2048 x 1536 pixels · CFP — 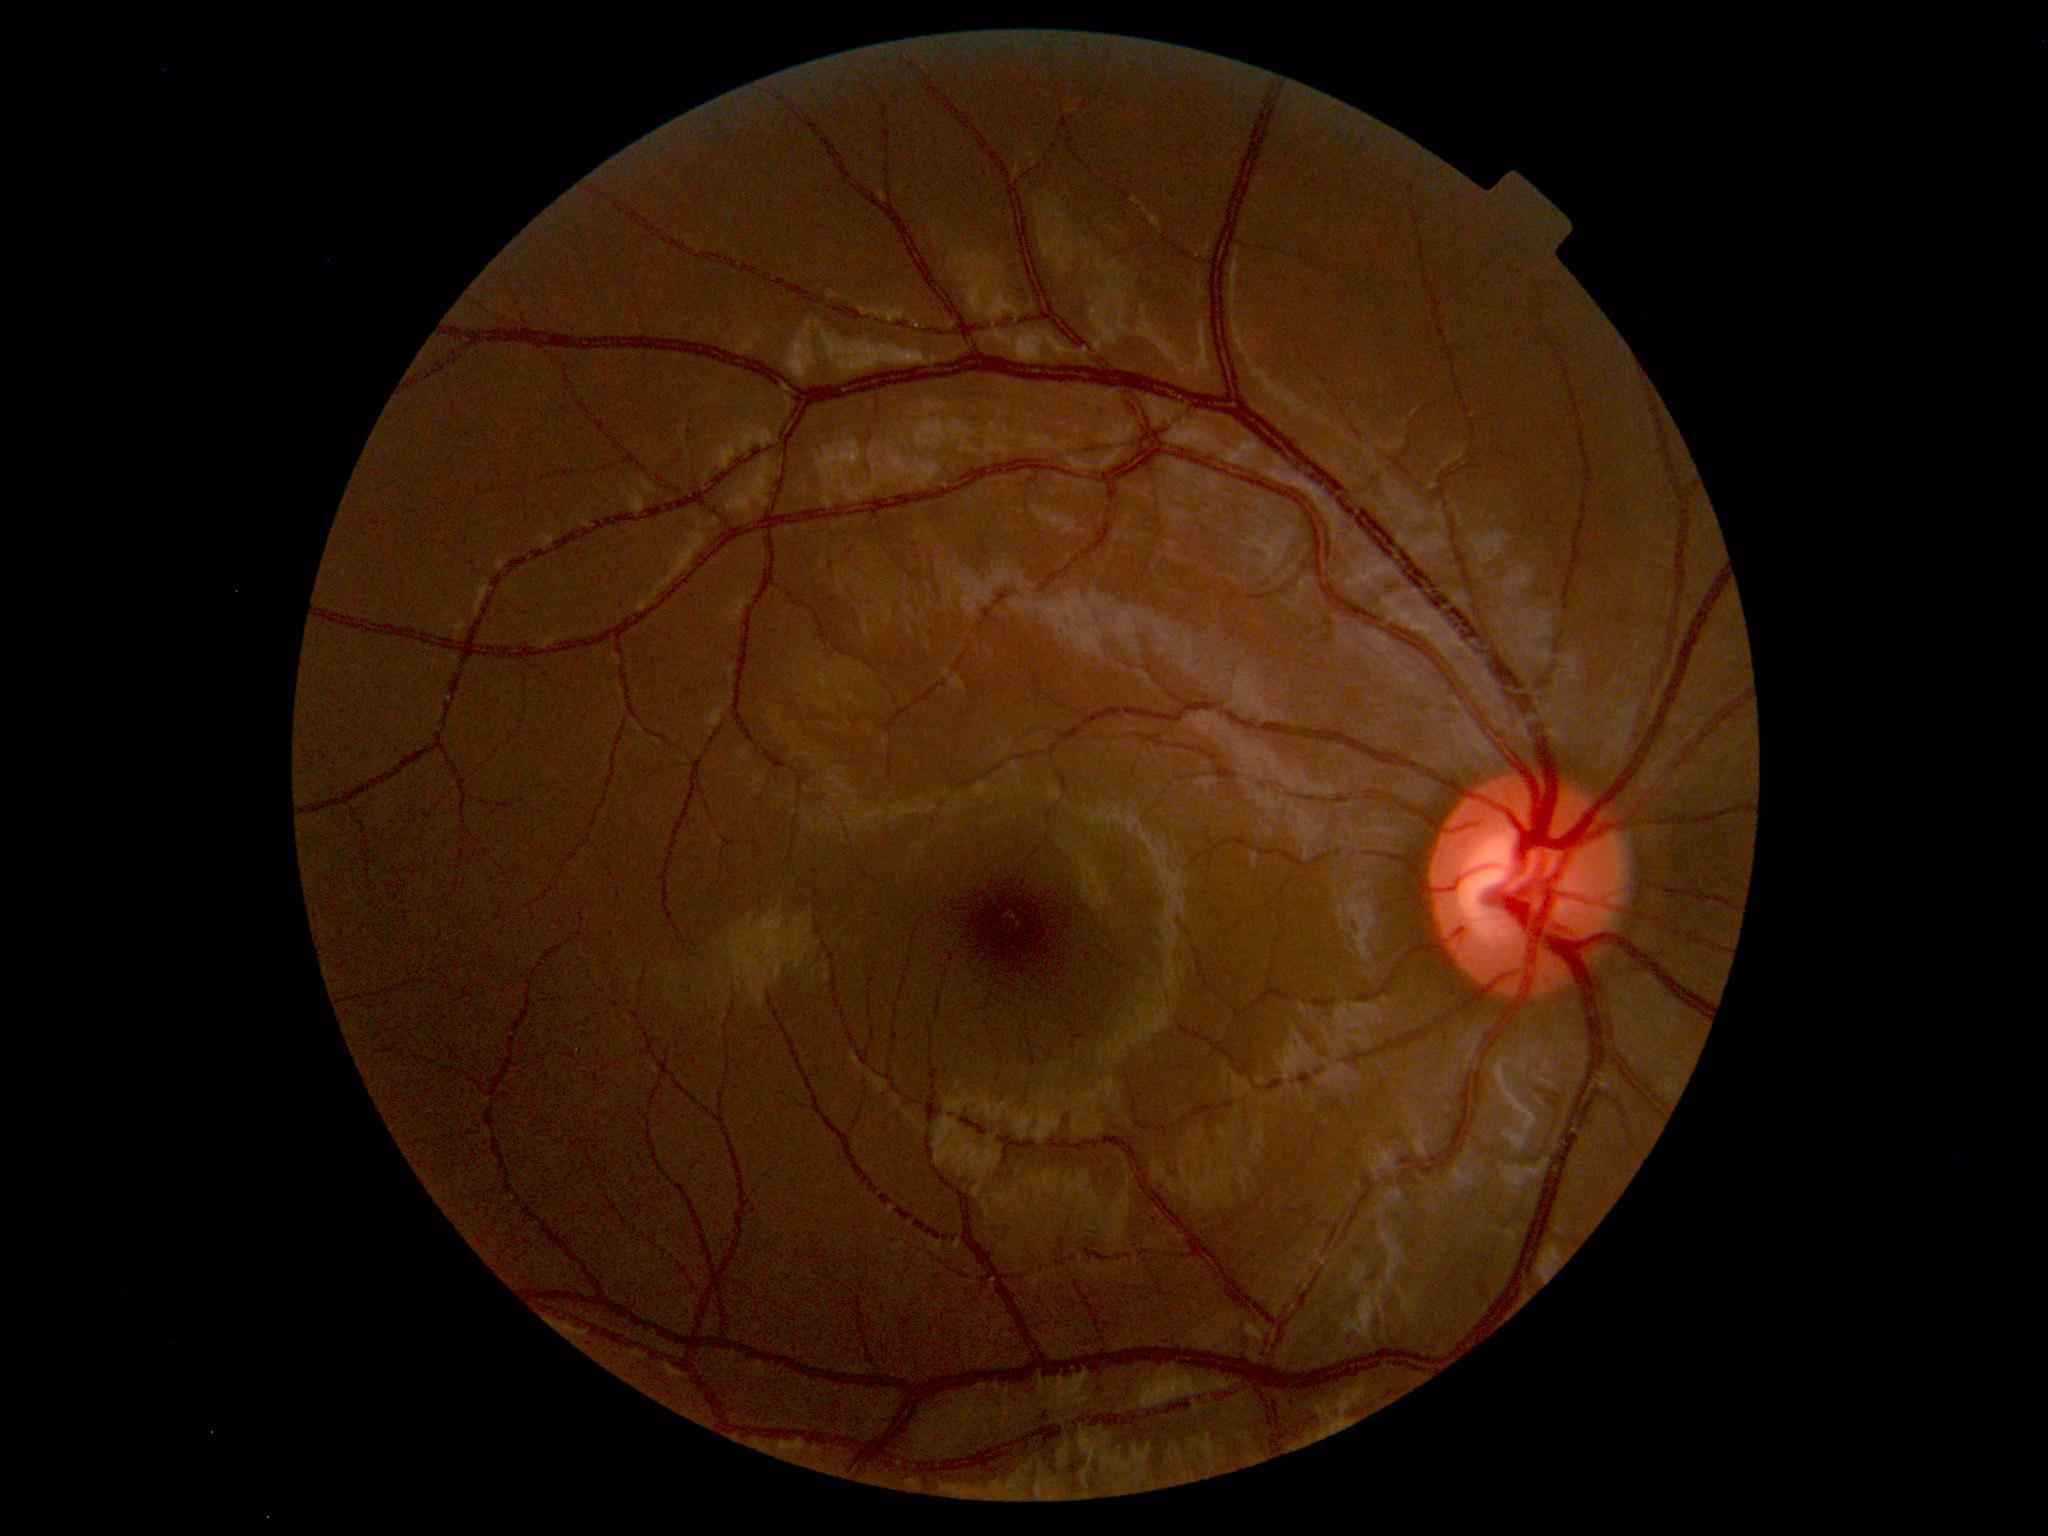

Impression: normal fundus.